Infant wide-field fundus photograph
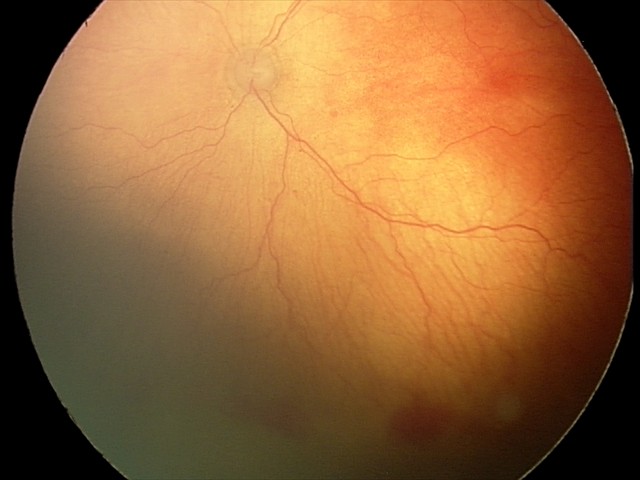
Diagnosis: A-ROP (aggressive ROP).